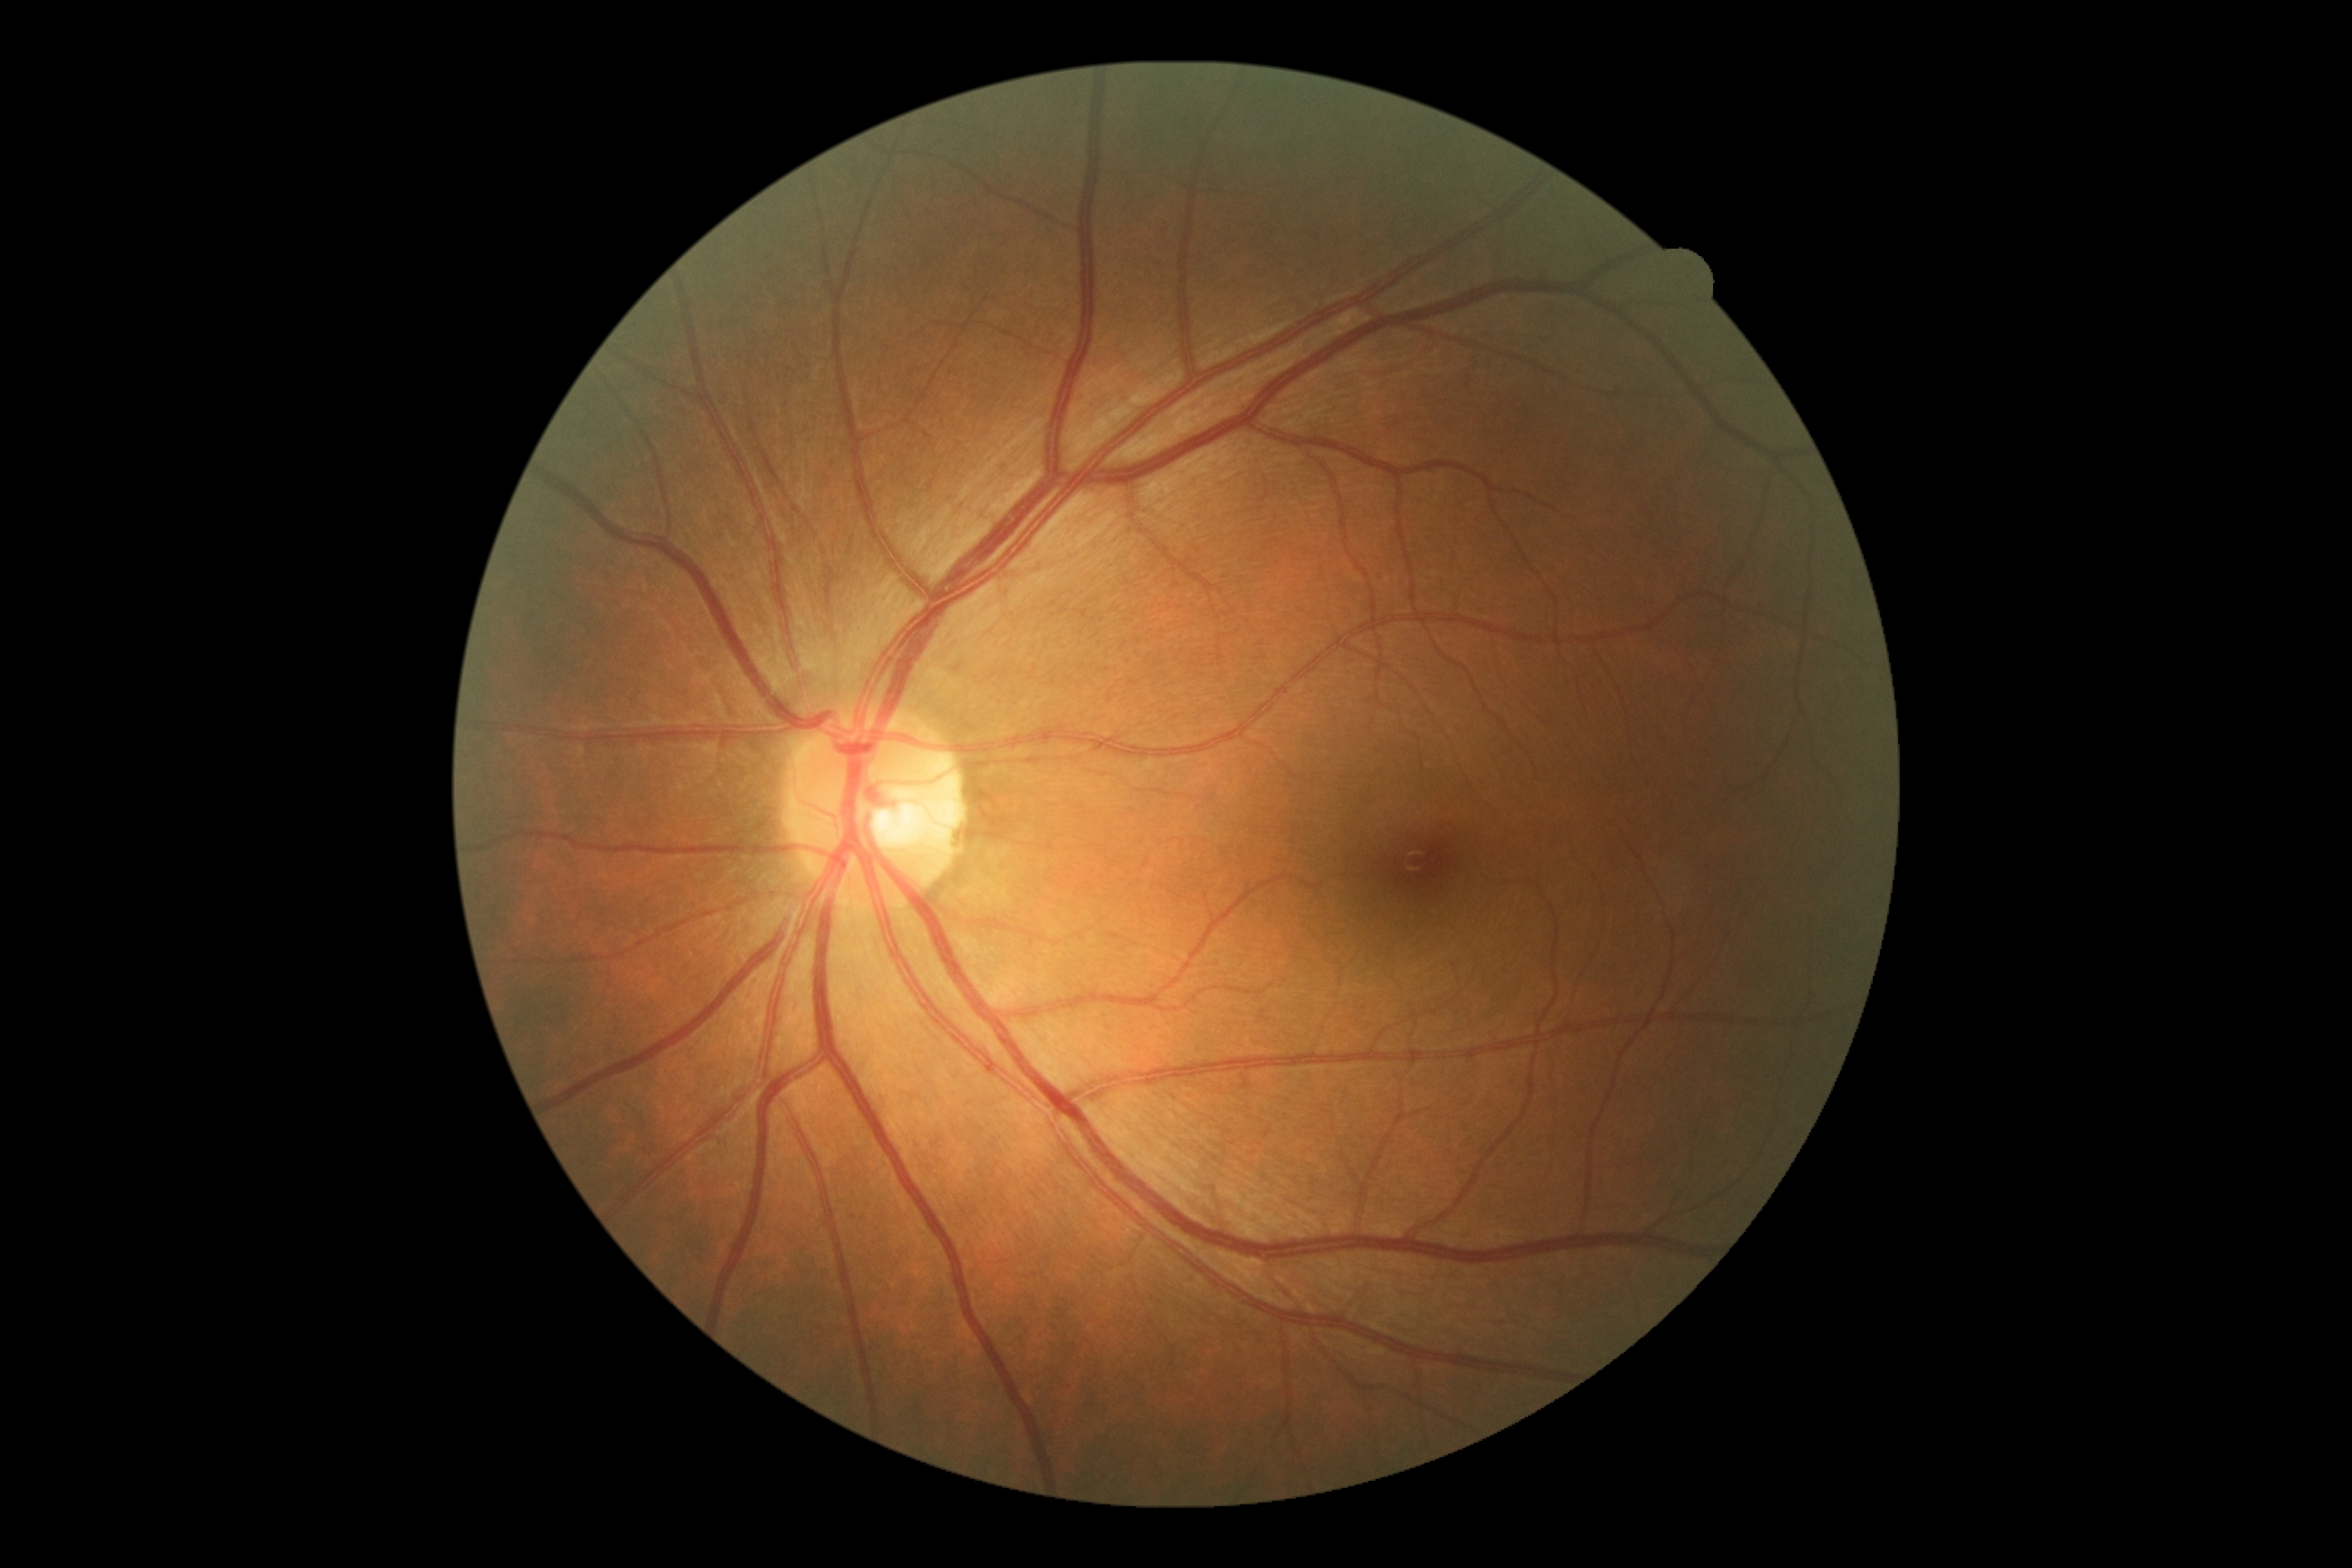 Diabetic retinopathy (DR): no apparent diabetic retinopathy (grade 0).